Retinal fundus photograph — 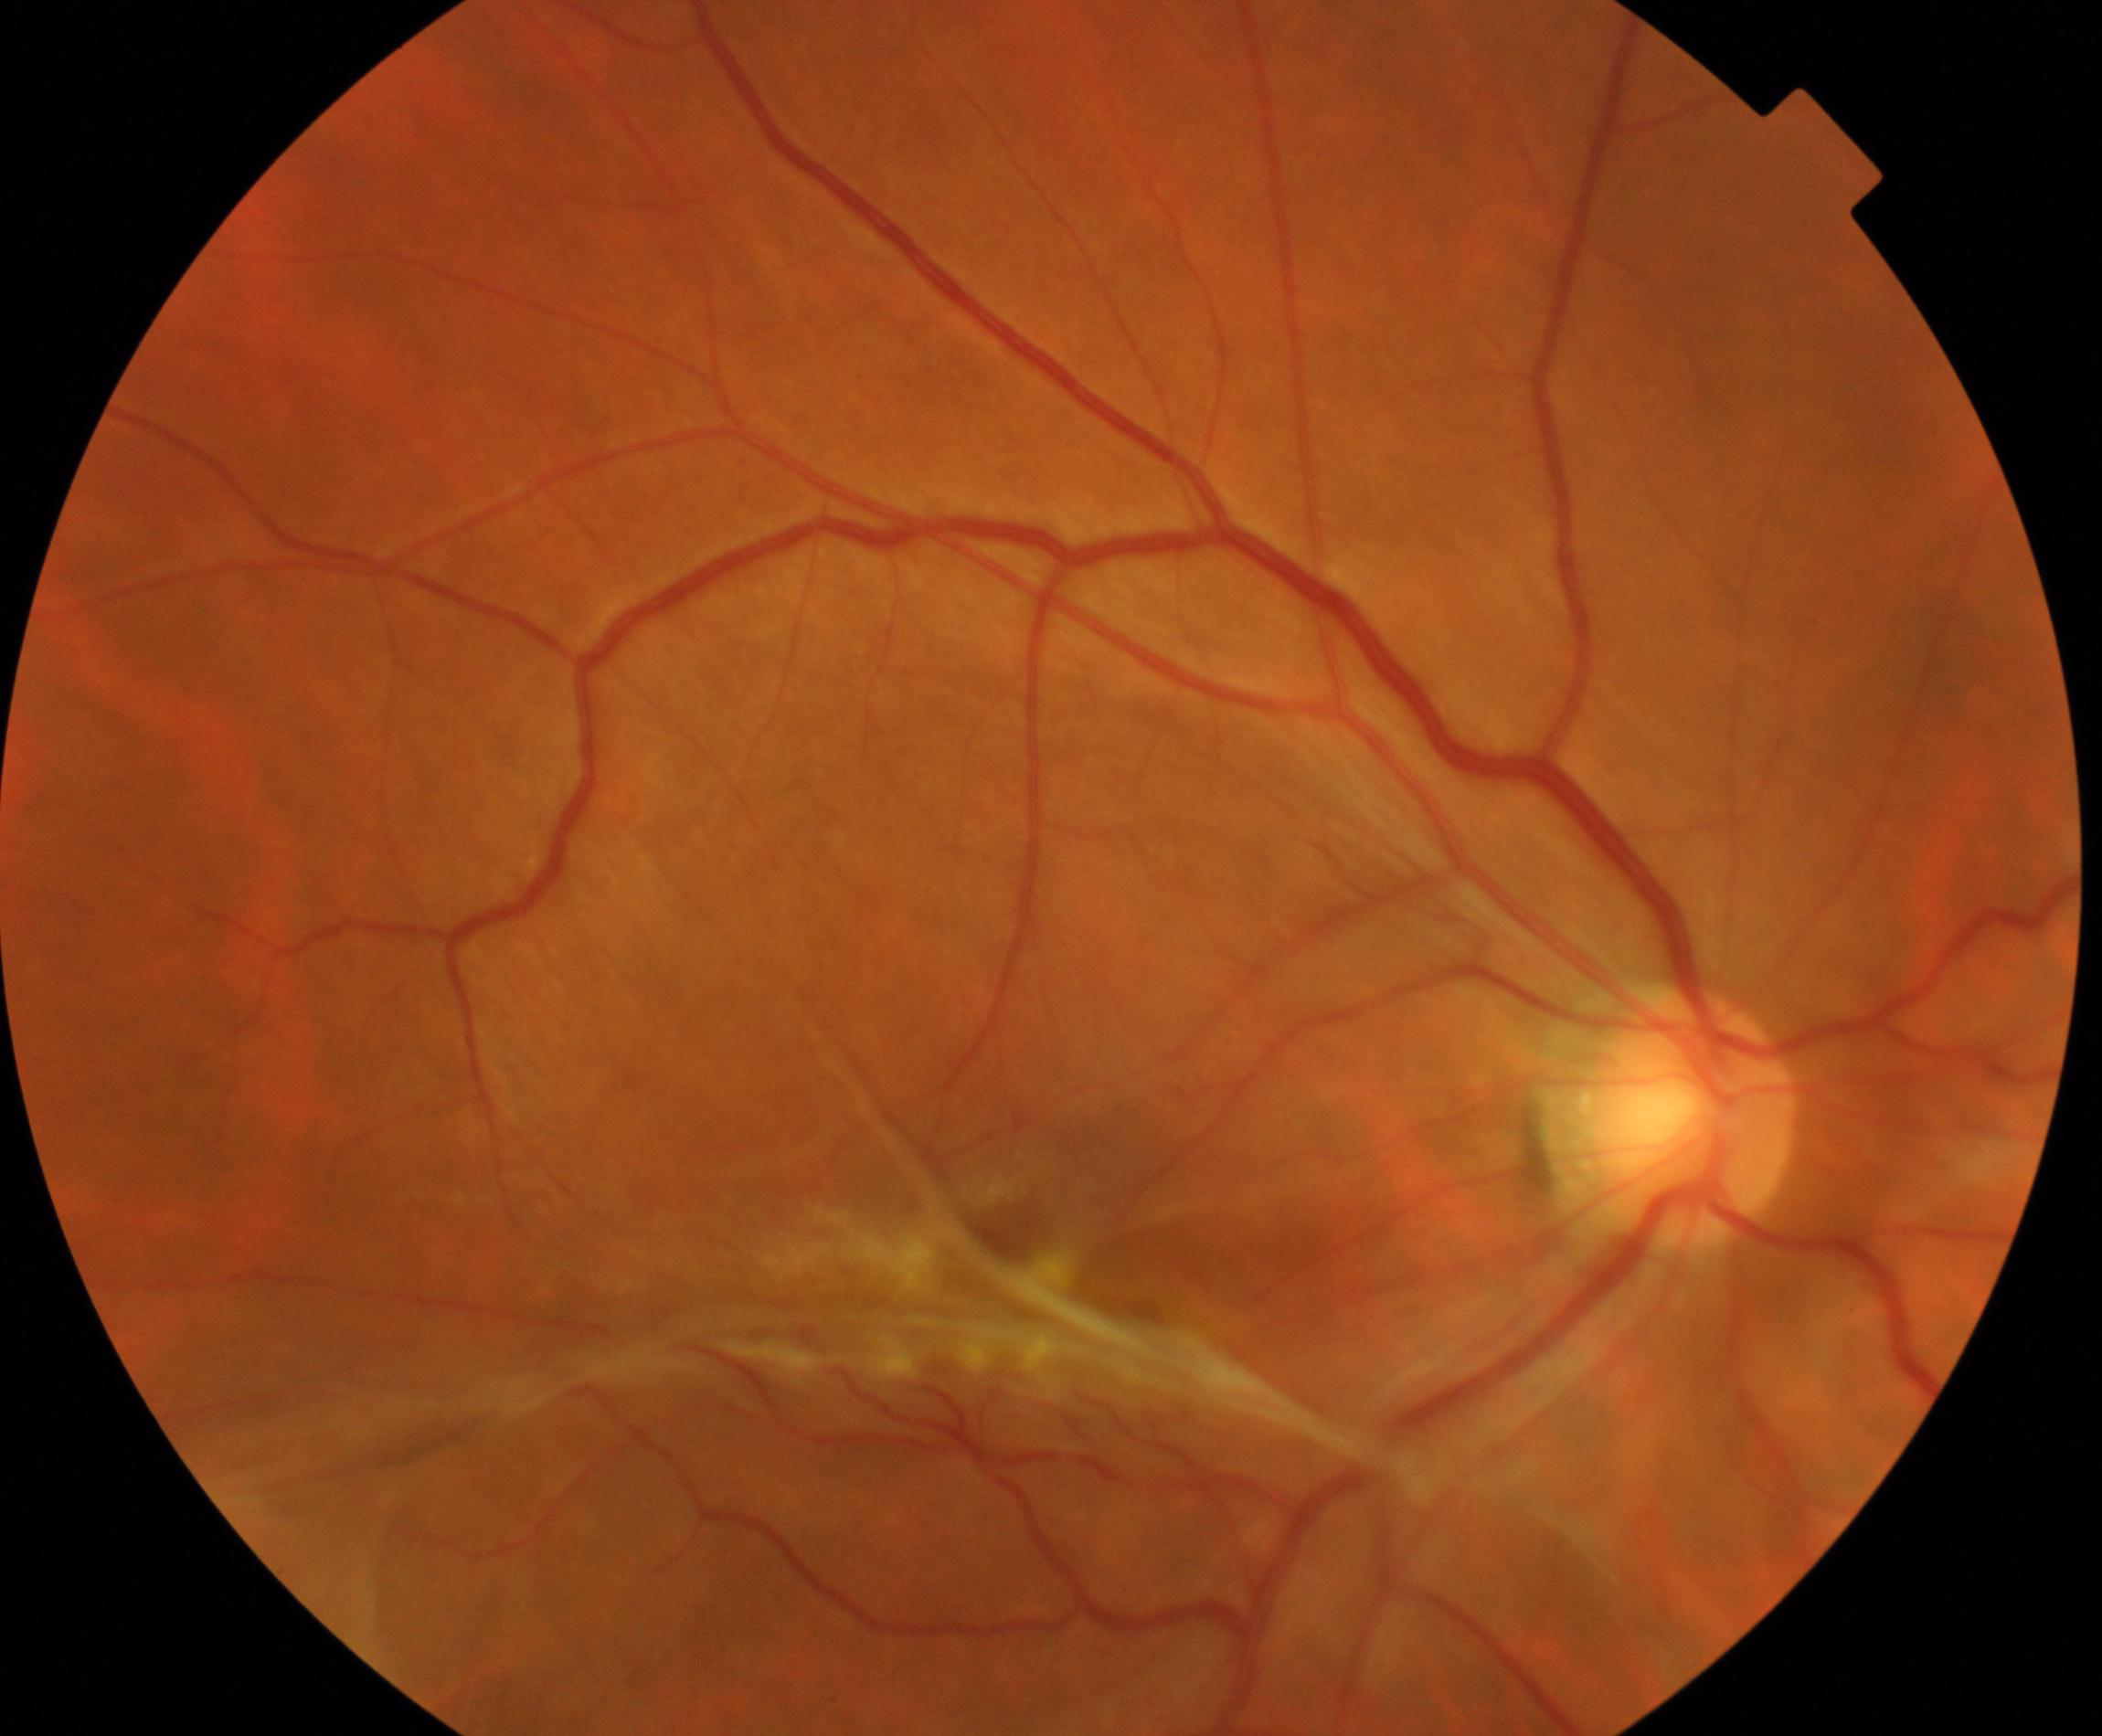

Findings consistent with fibrosis. Features include irregular grayish-white opacification, often with distortion of the retinal vasculature, crossing the vessel arcades.